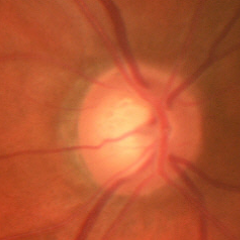
Glaucomatous changes are present.
Early glaucomatous optic neuropathy.
Diagnostic criteria: glaucomatous retinal nerve fiber layer defects on red-free fundus photography without visual field defects.